240 by 240 pixels: 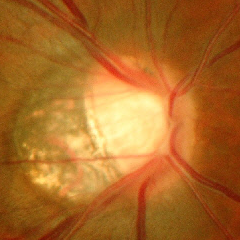
Findings consistent with glaucoma. Showing advanced glaucoma.